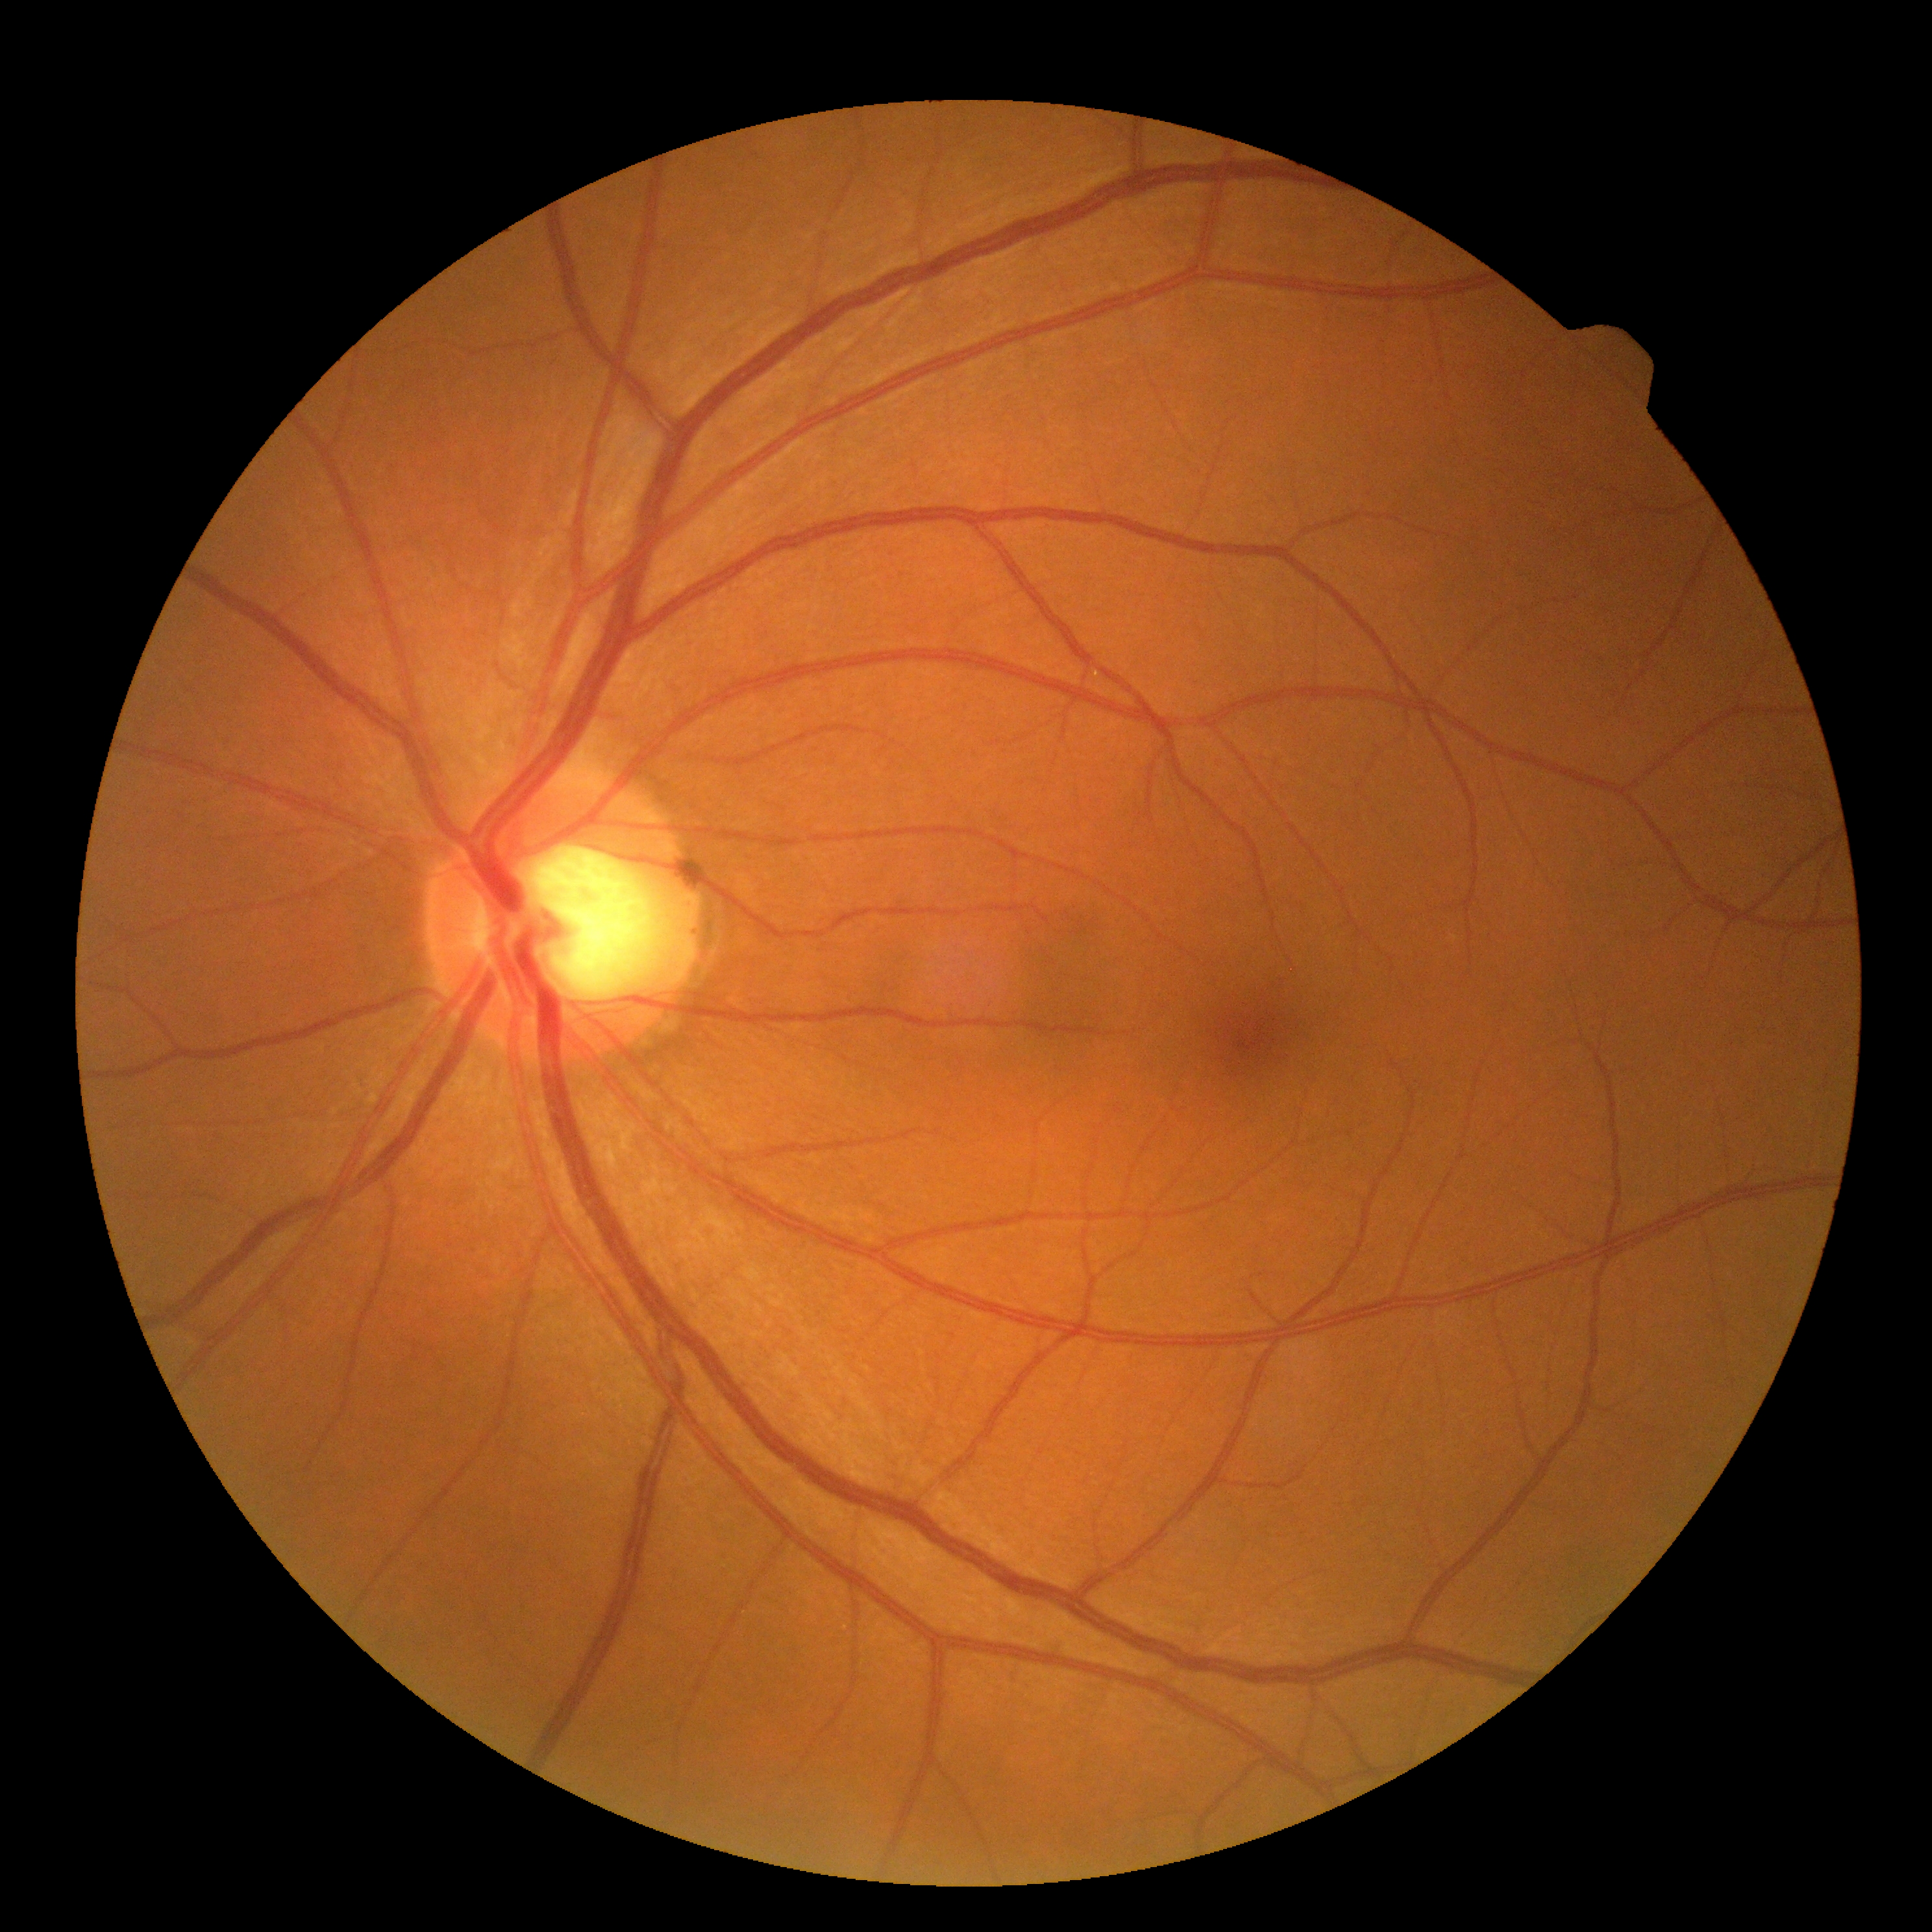

DR grade = 0, DR impression = no apparent DR.